45-degree field of view, 1932 x 1910 pixels: 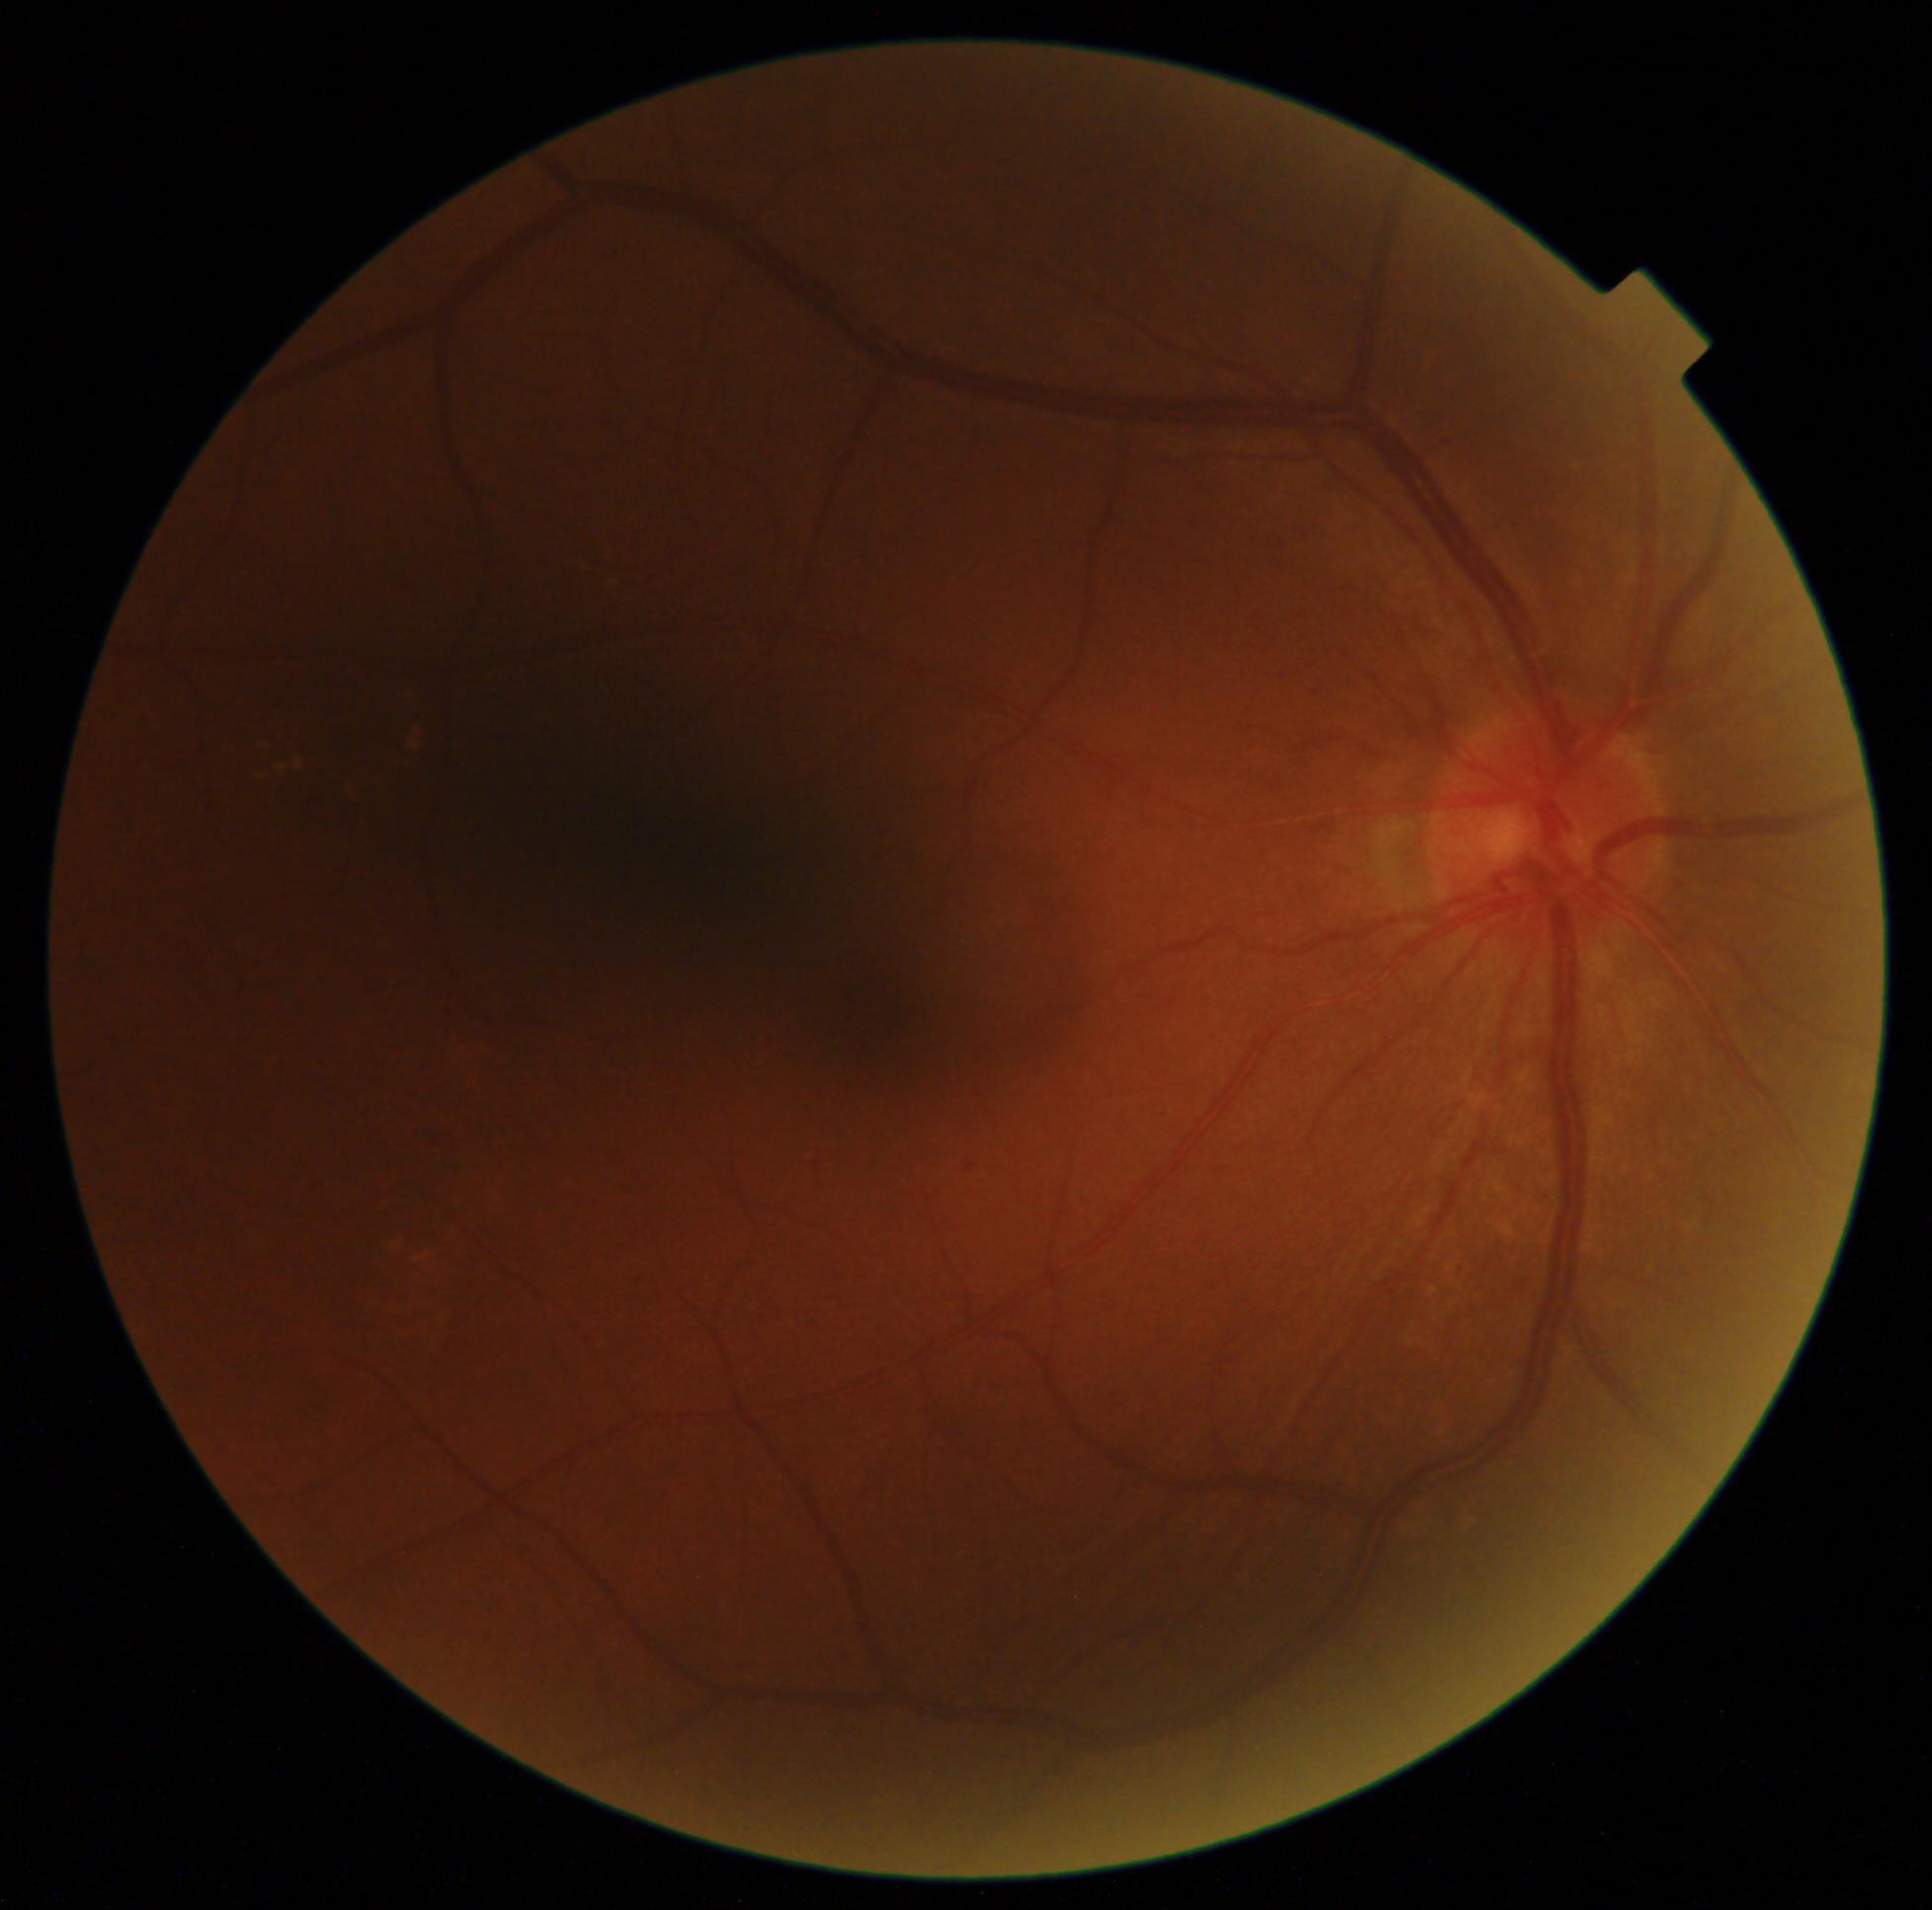

DR severity: grade 2 (moderate NPDR).